Wide-field fundus photograph from neonatal ROP screening
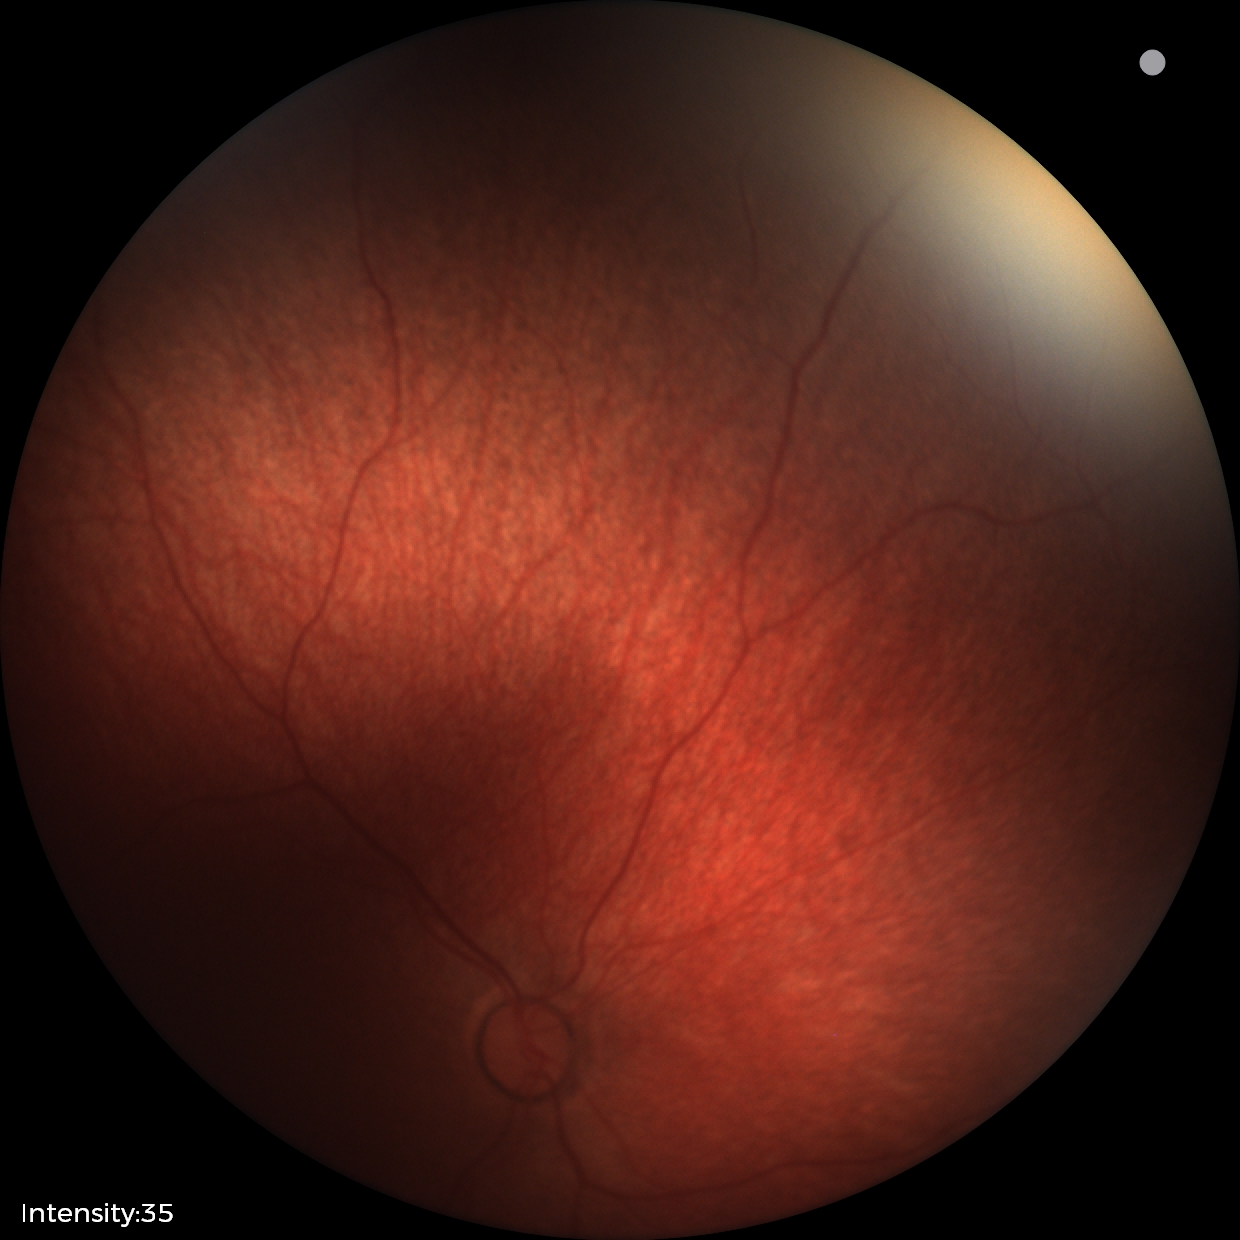

Q: What was the screening finding?
A: no abnormal retinal findings